Image size 1470x1137 · 45-degree field of view:
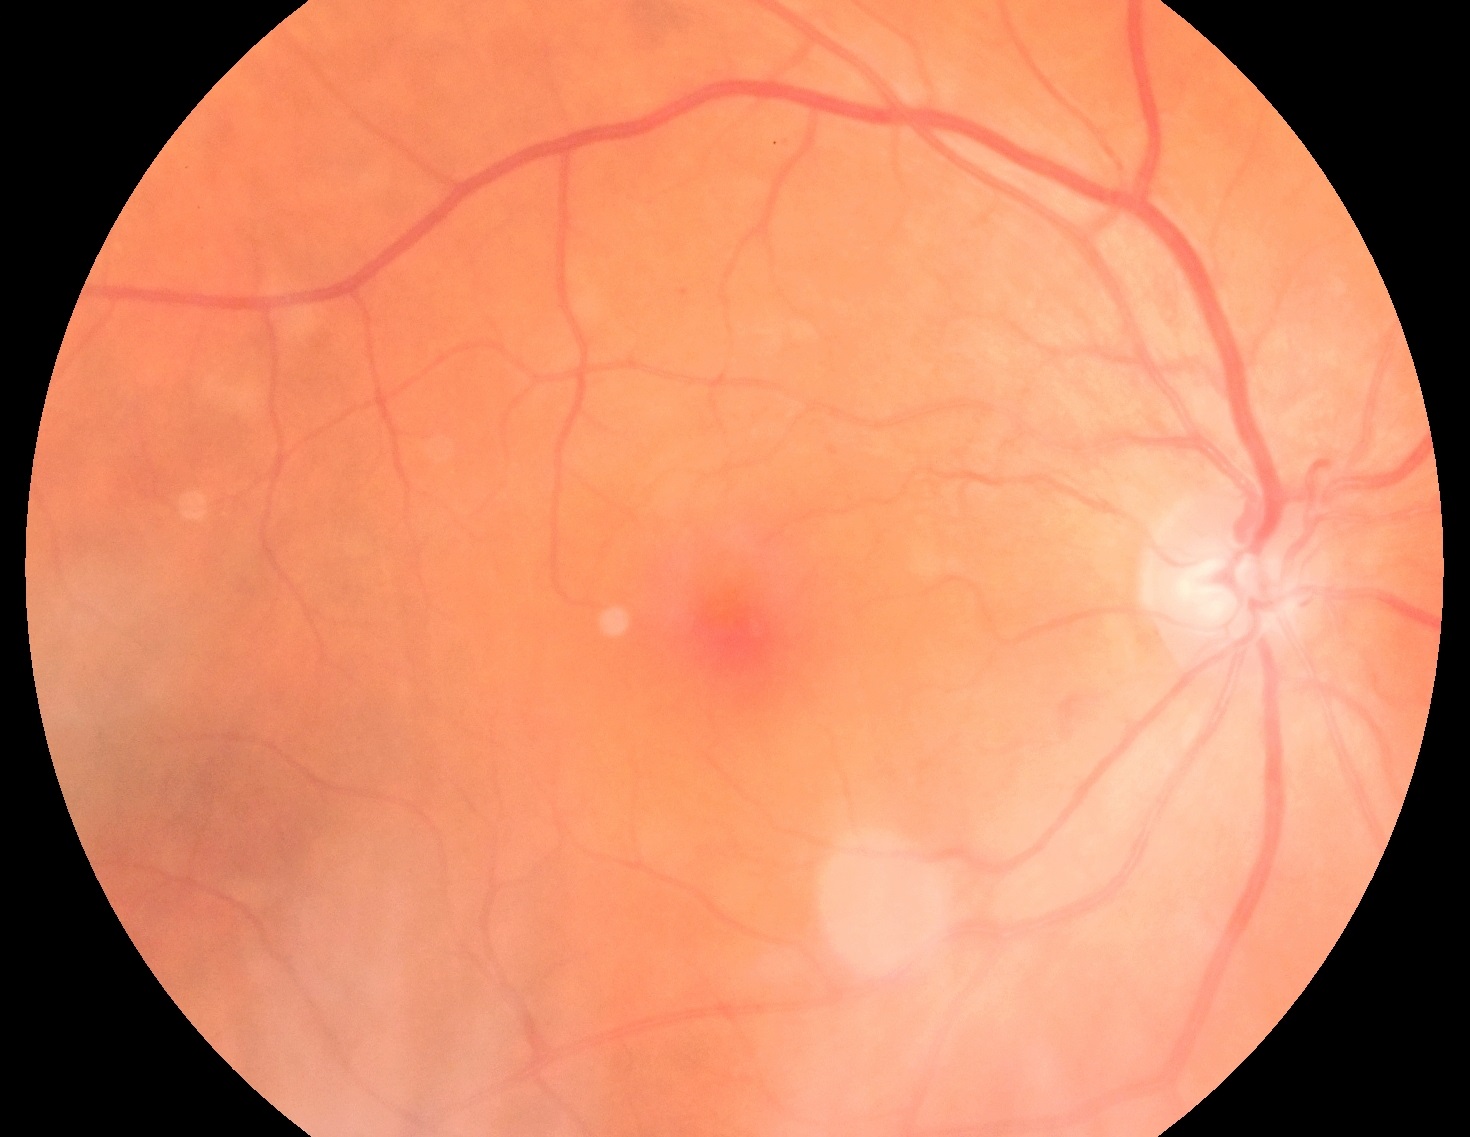
Diabetic retinopathy is grade 2.